Wide-field fundus photograph of an infant; camera: Phoenix ICON (100° FOV); 1240 by 1240 pixels: 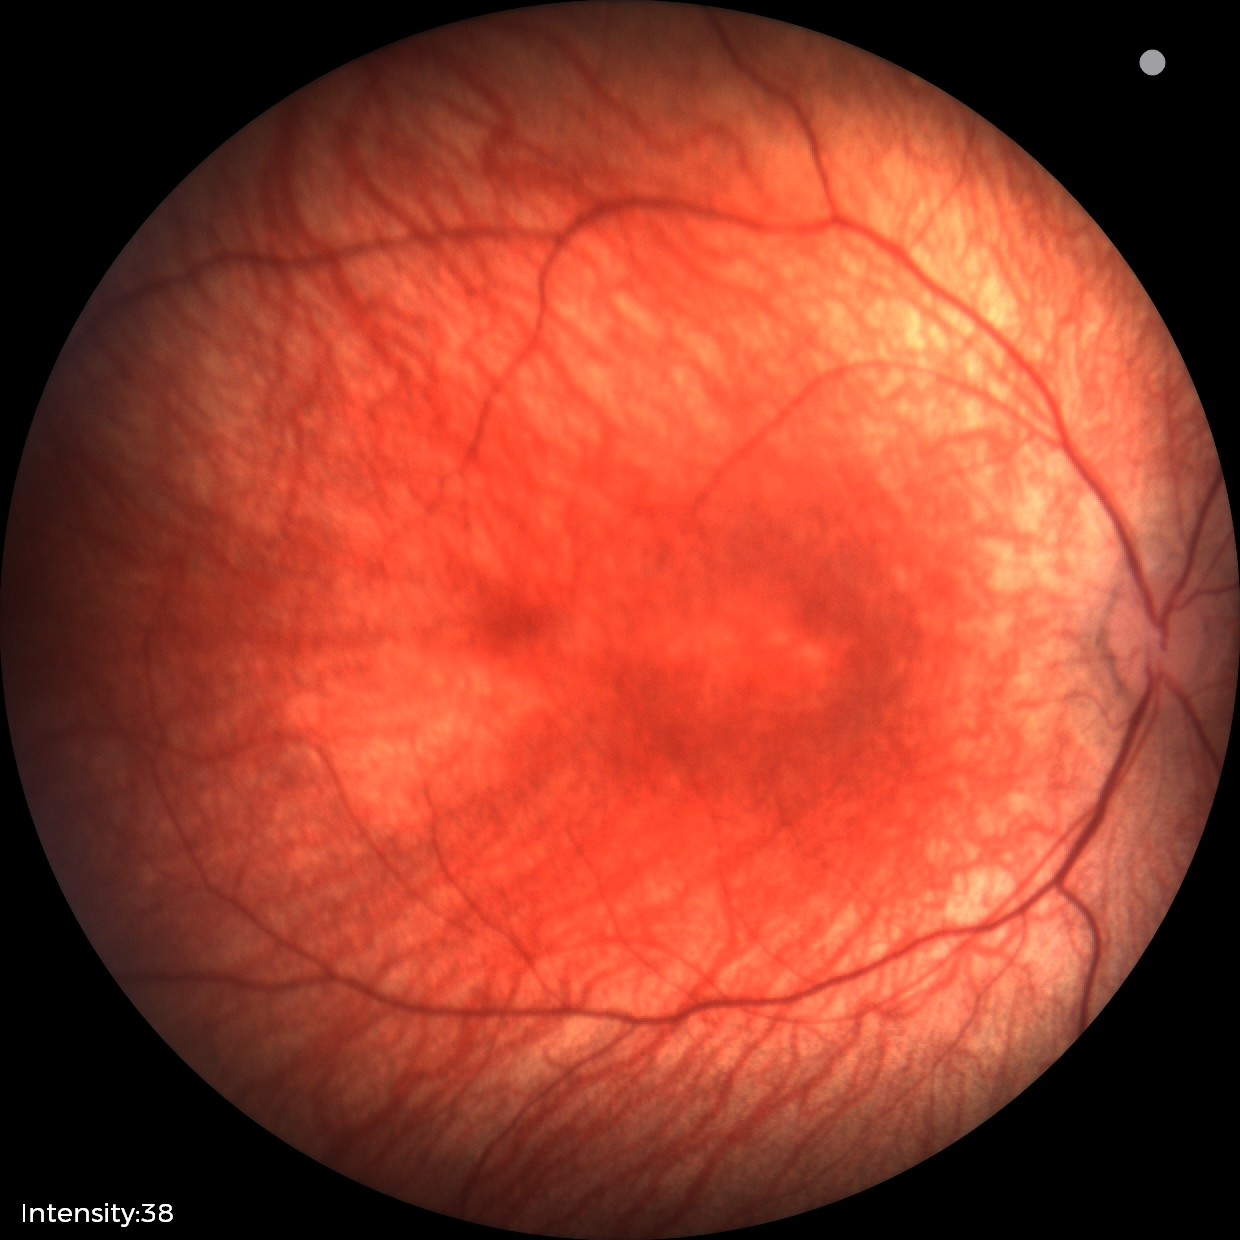 Assessment: physiological appearance with no retinal pathology.